1536x1152px, CFP:
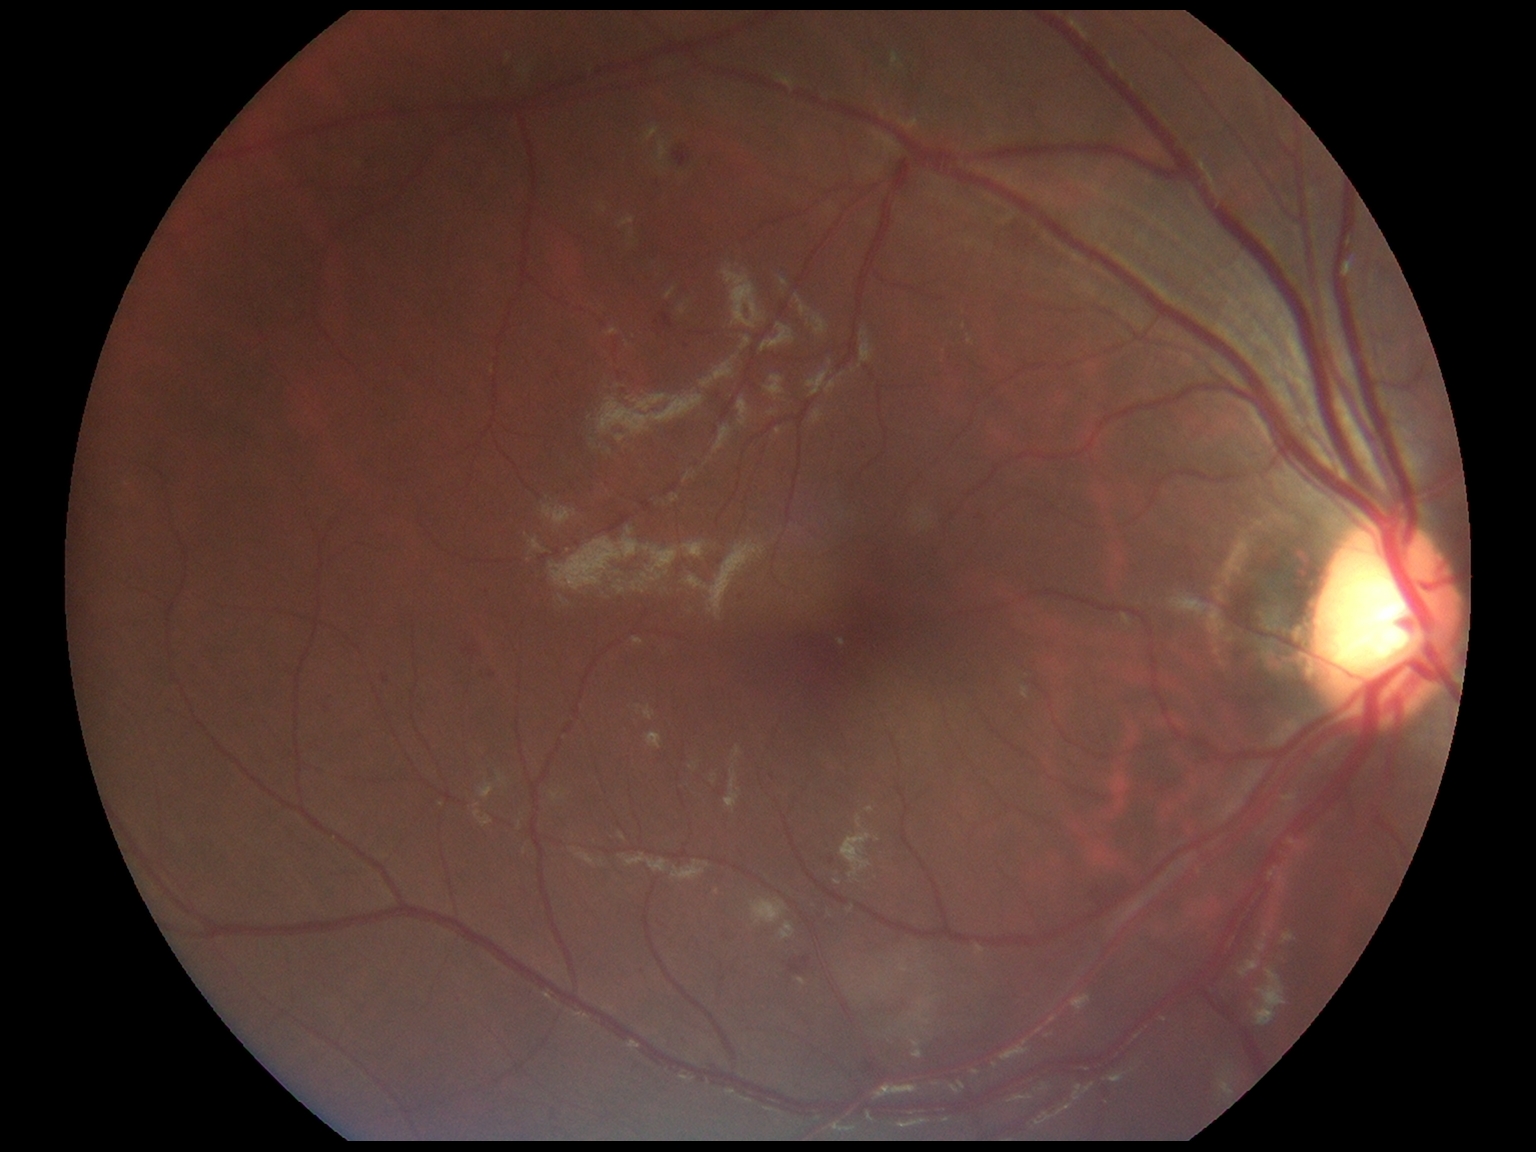
Diabetic retinopathy severity: grade 2.